Color fundus image. 848 by 848 pixels. Without pupil dilation.
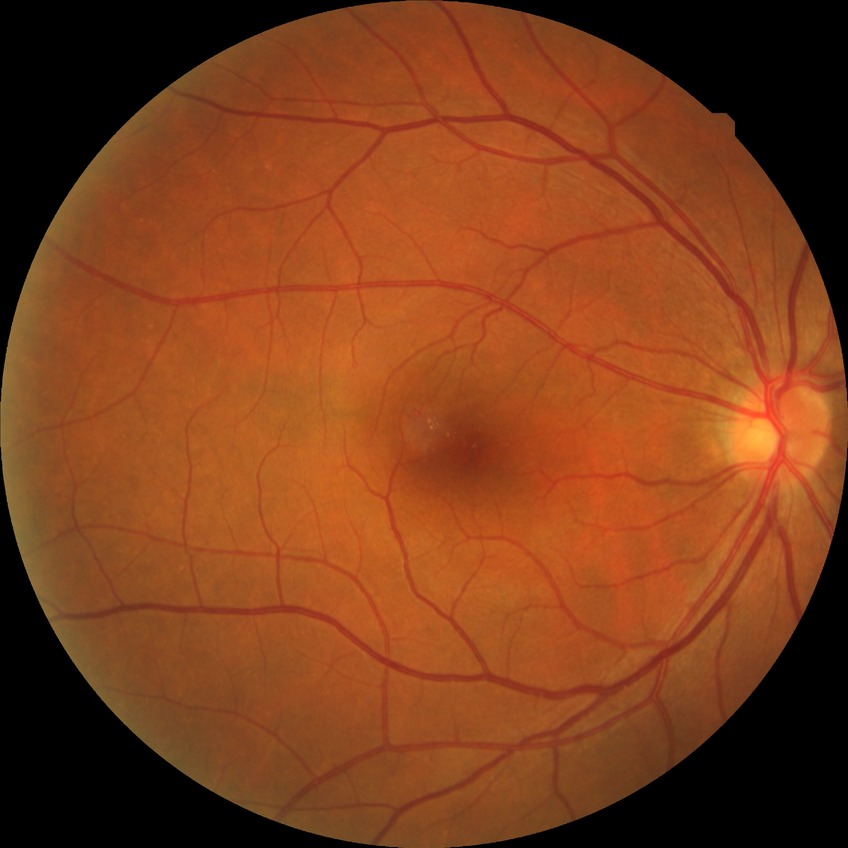 DR class: non-proliferative diabetic retinopathy.
Retinopathy grade: simple diabetic retinopathy.